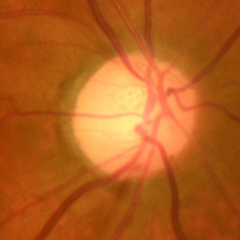

Early glaucomatous optic neuropathy.